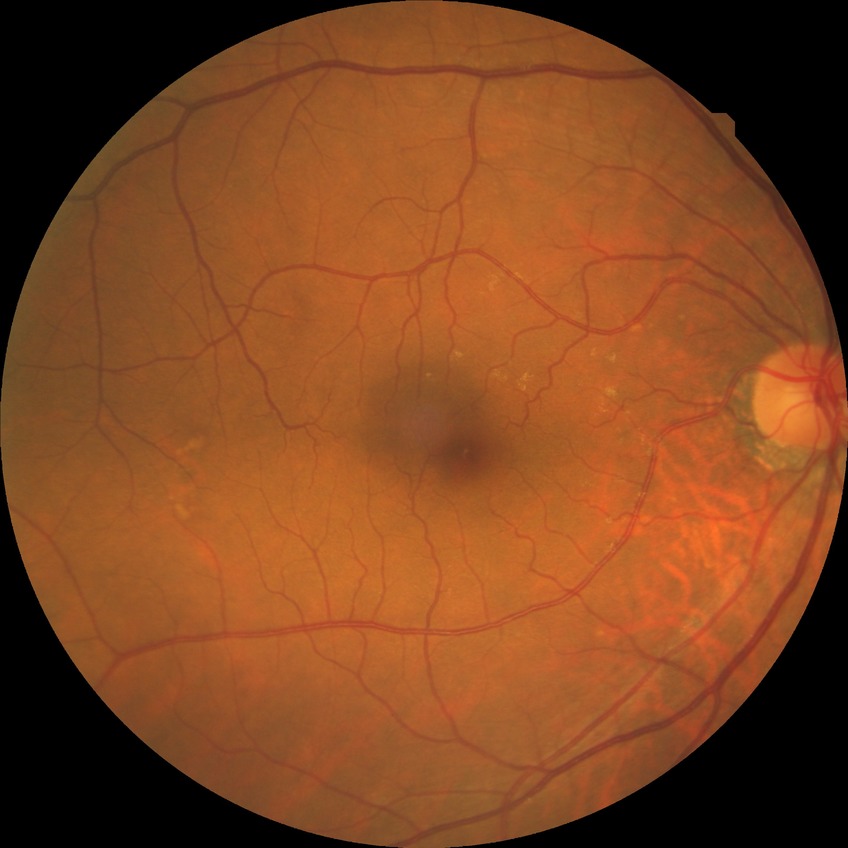
{"davis_grade": "no diabetic retinopathy"}